Diabetic retinopathy graded by the modified Davis classification:
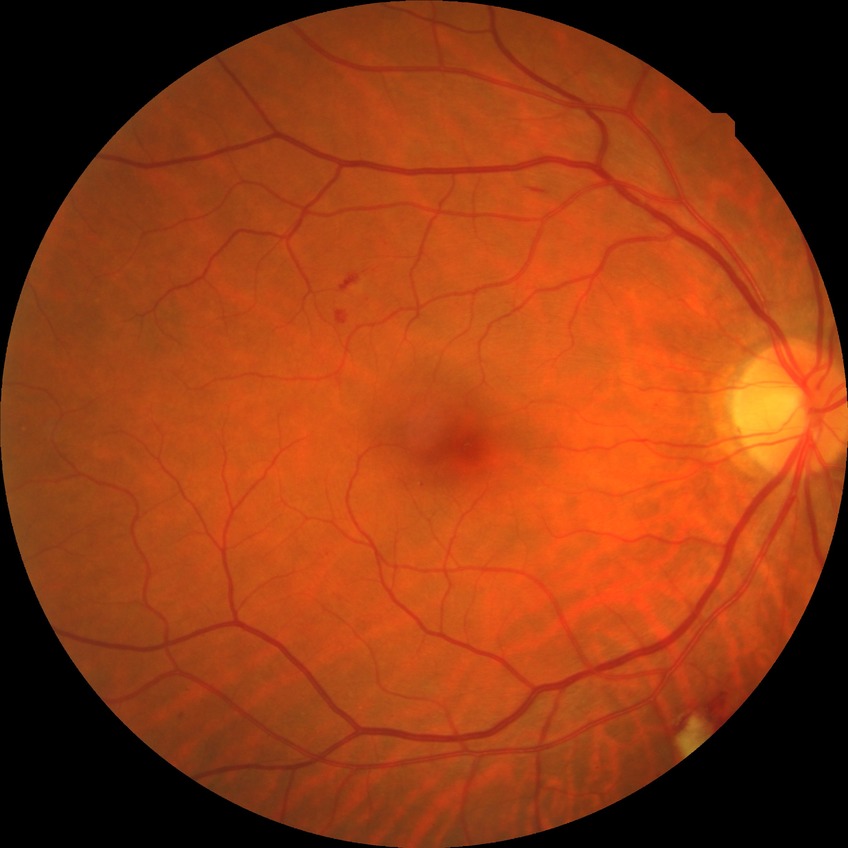

Diabetic retinopathy (DR) is SDR (simple diabetic retinopathy).
The retinopathy is classified as non-proliferative diabetic retinopathy.